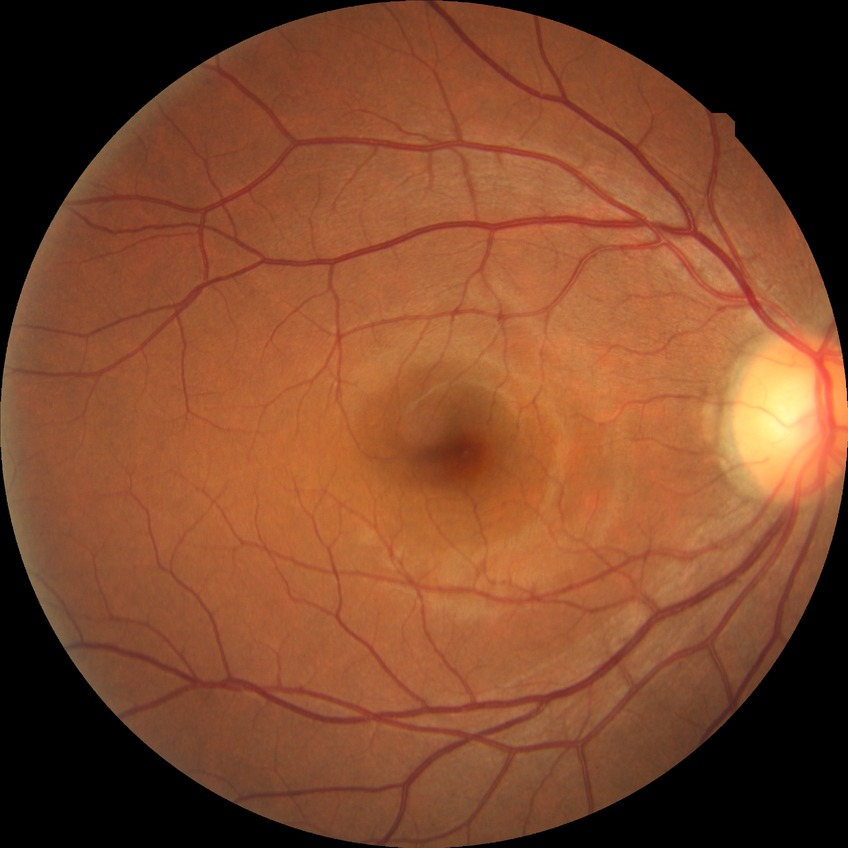
Assessment:
- retinopathy grade: no diabetic retinopathy